Ultra-widefield fundus photograph
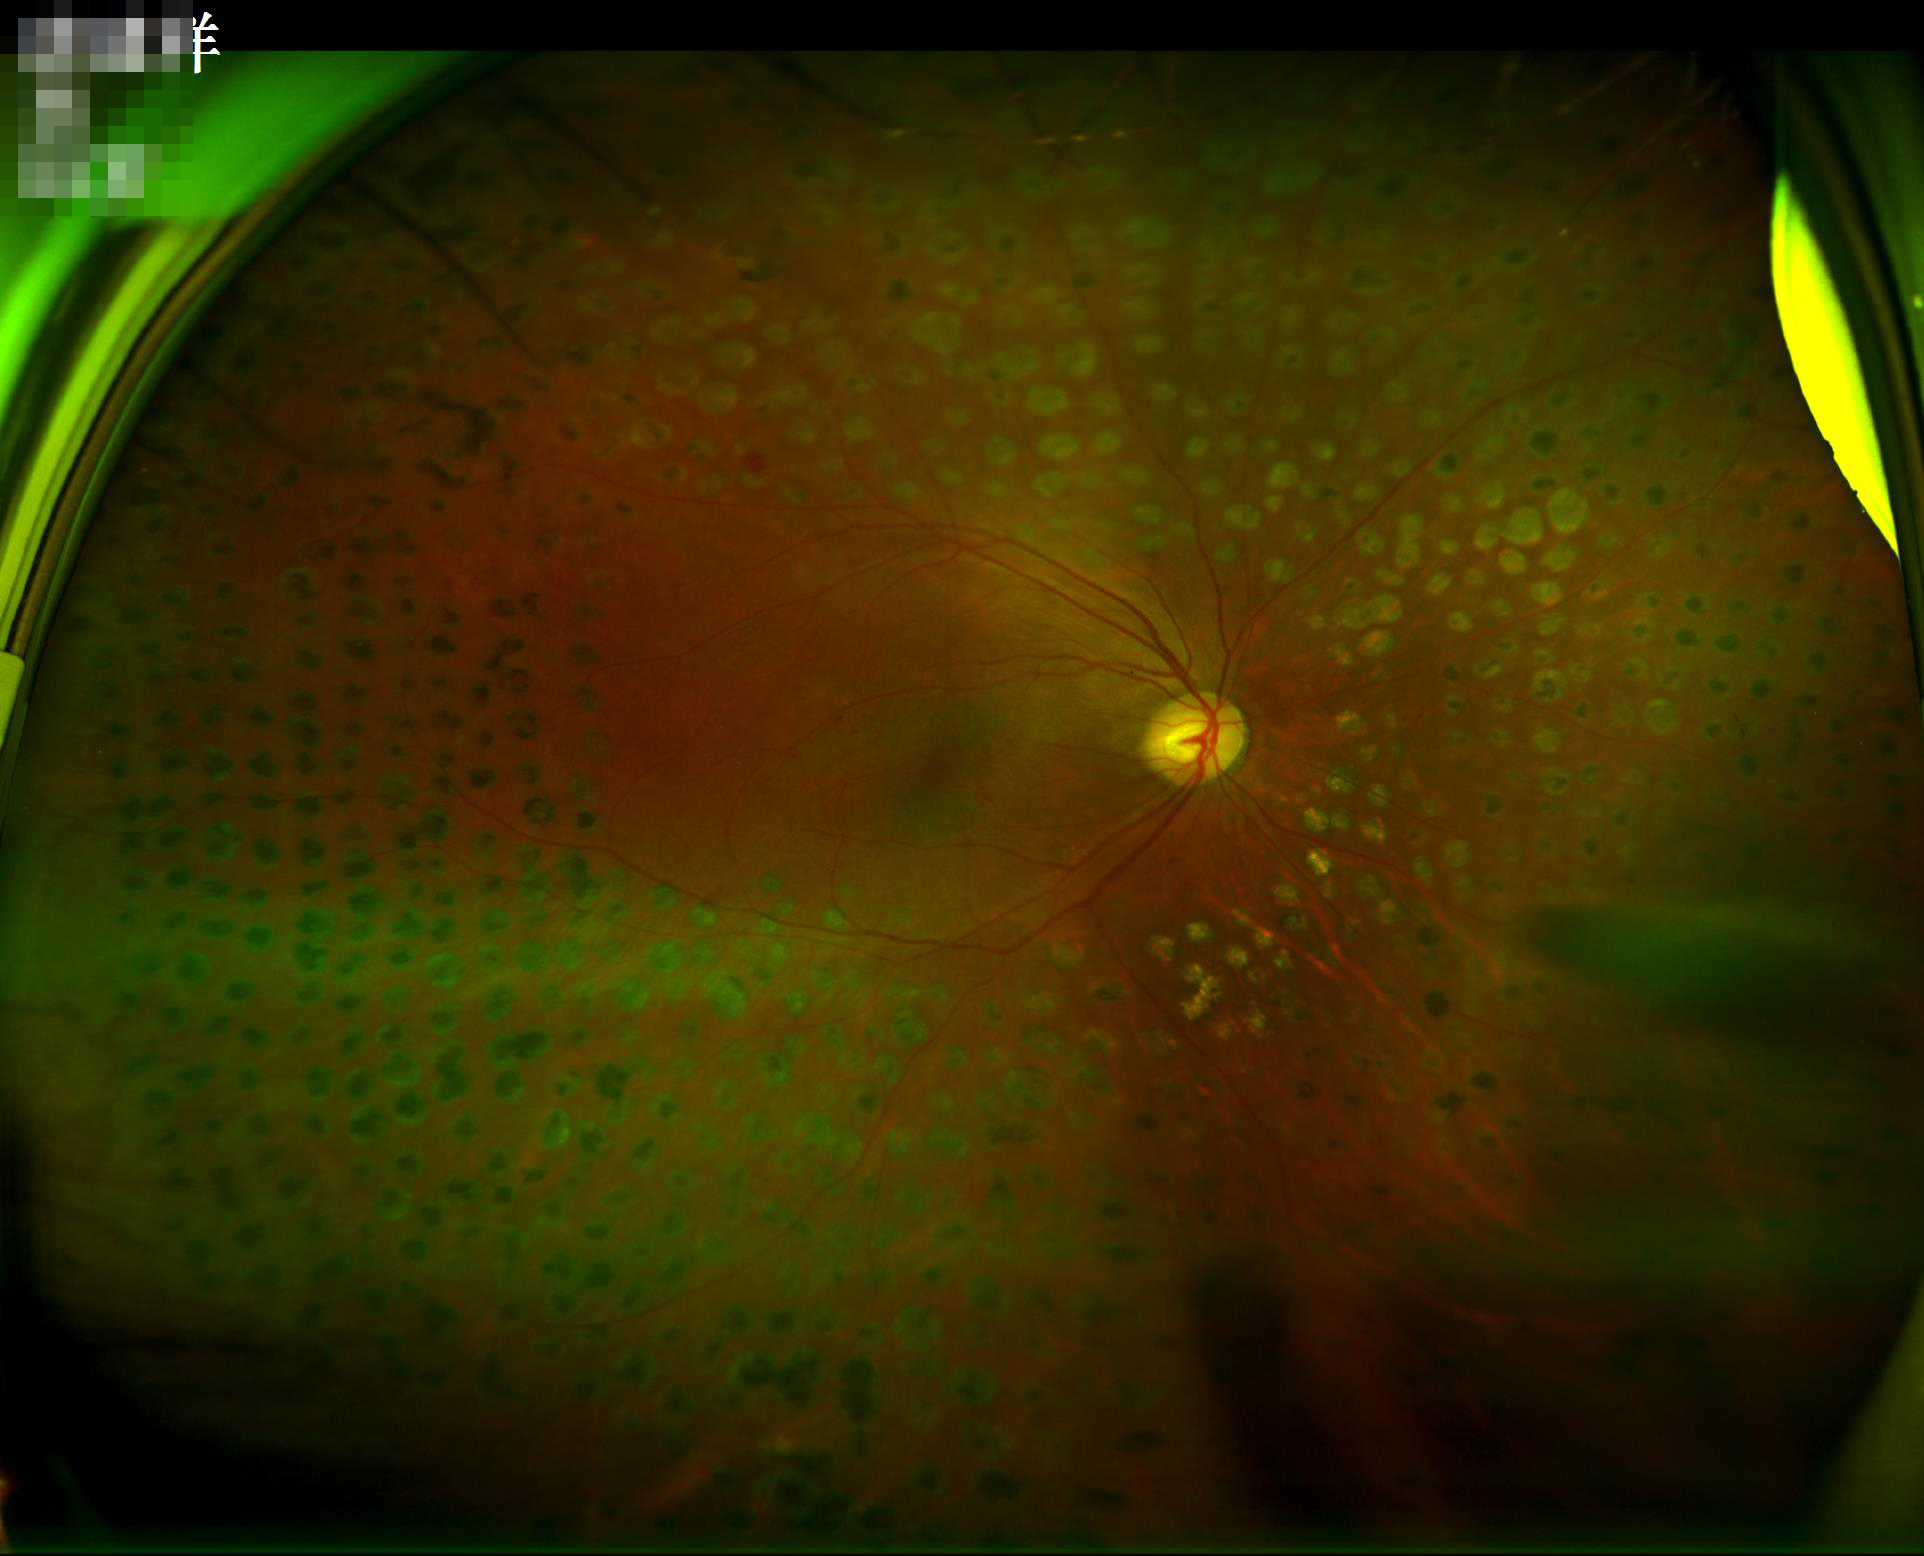 Quality assessment:
- illumination: over- or under-exposed
- clarity: noticeable blur in the optic disc, vessels, or background
- overall: poor and difficult to use diagnostically
- contrast: good dynamic range